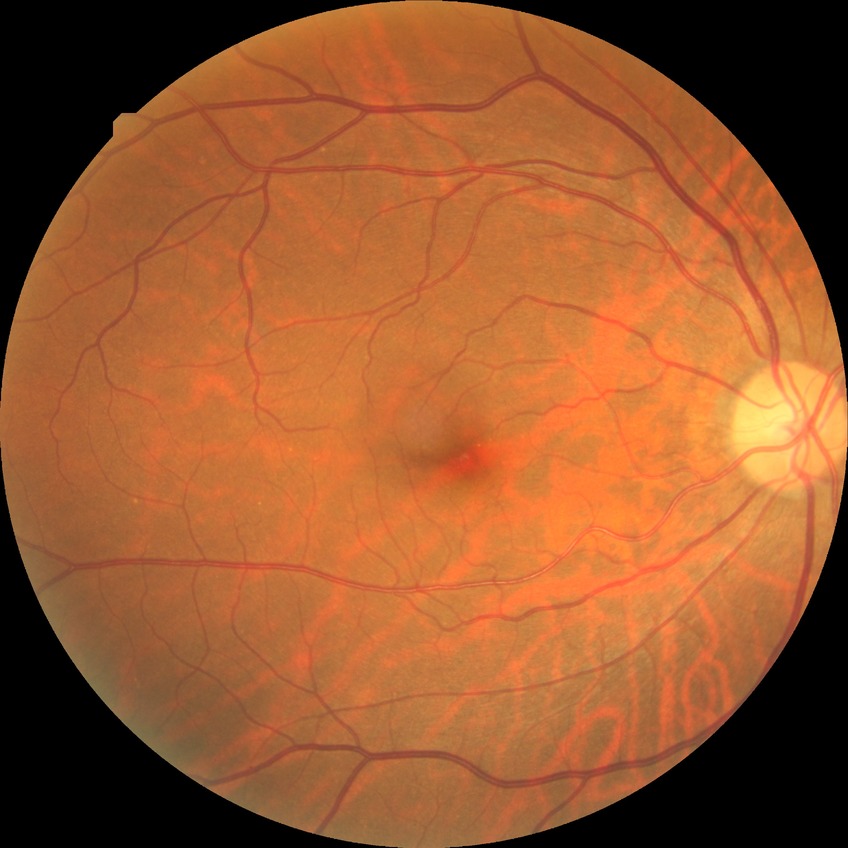

- diabetic retinopathy grade — no diabetic retinopathy